CFP. 45-degree field of view. Image size 2352x1568
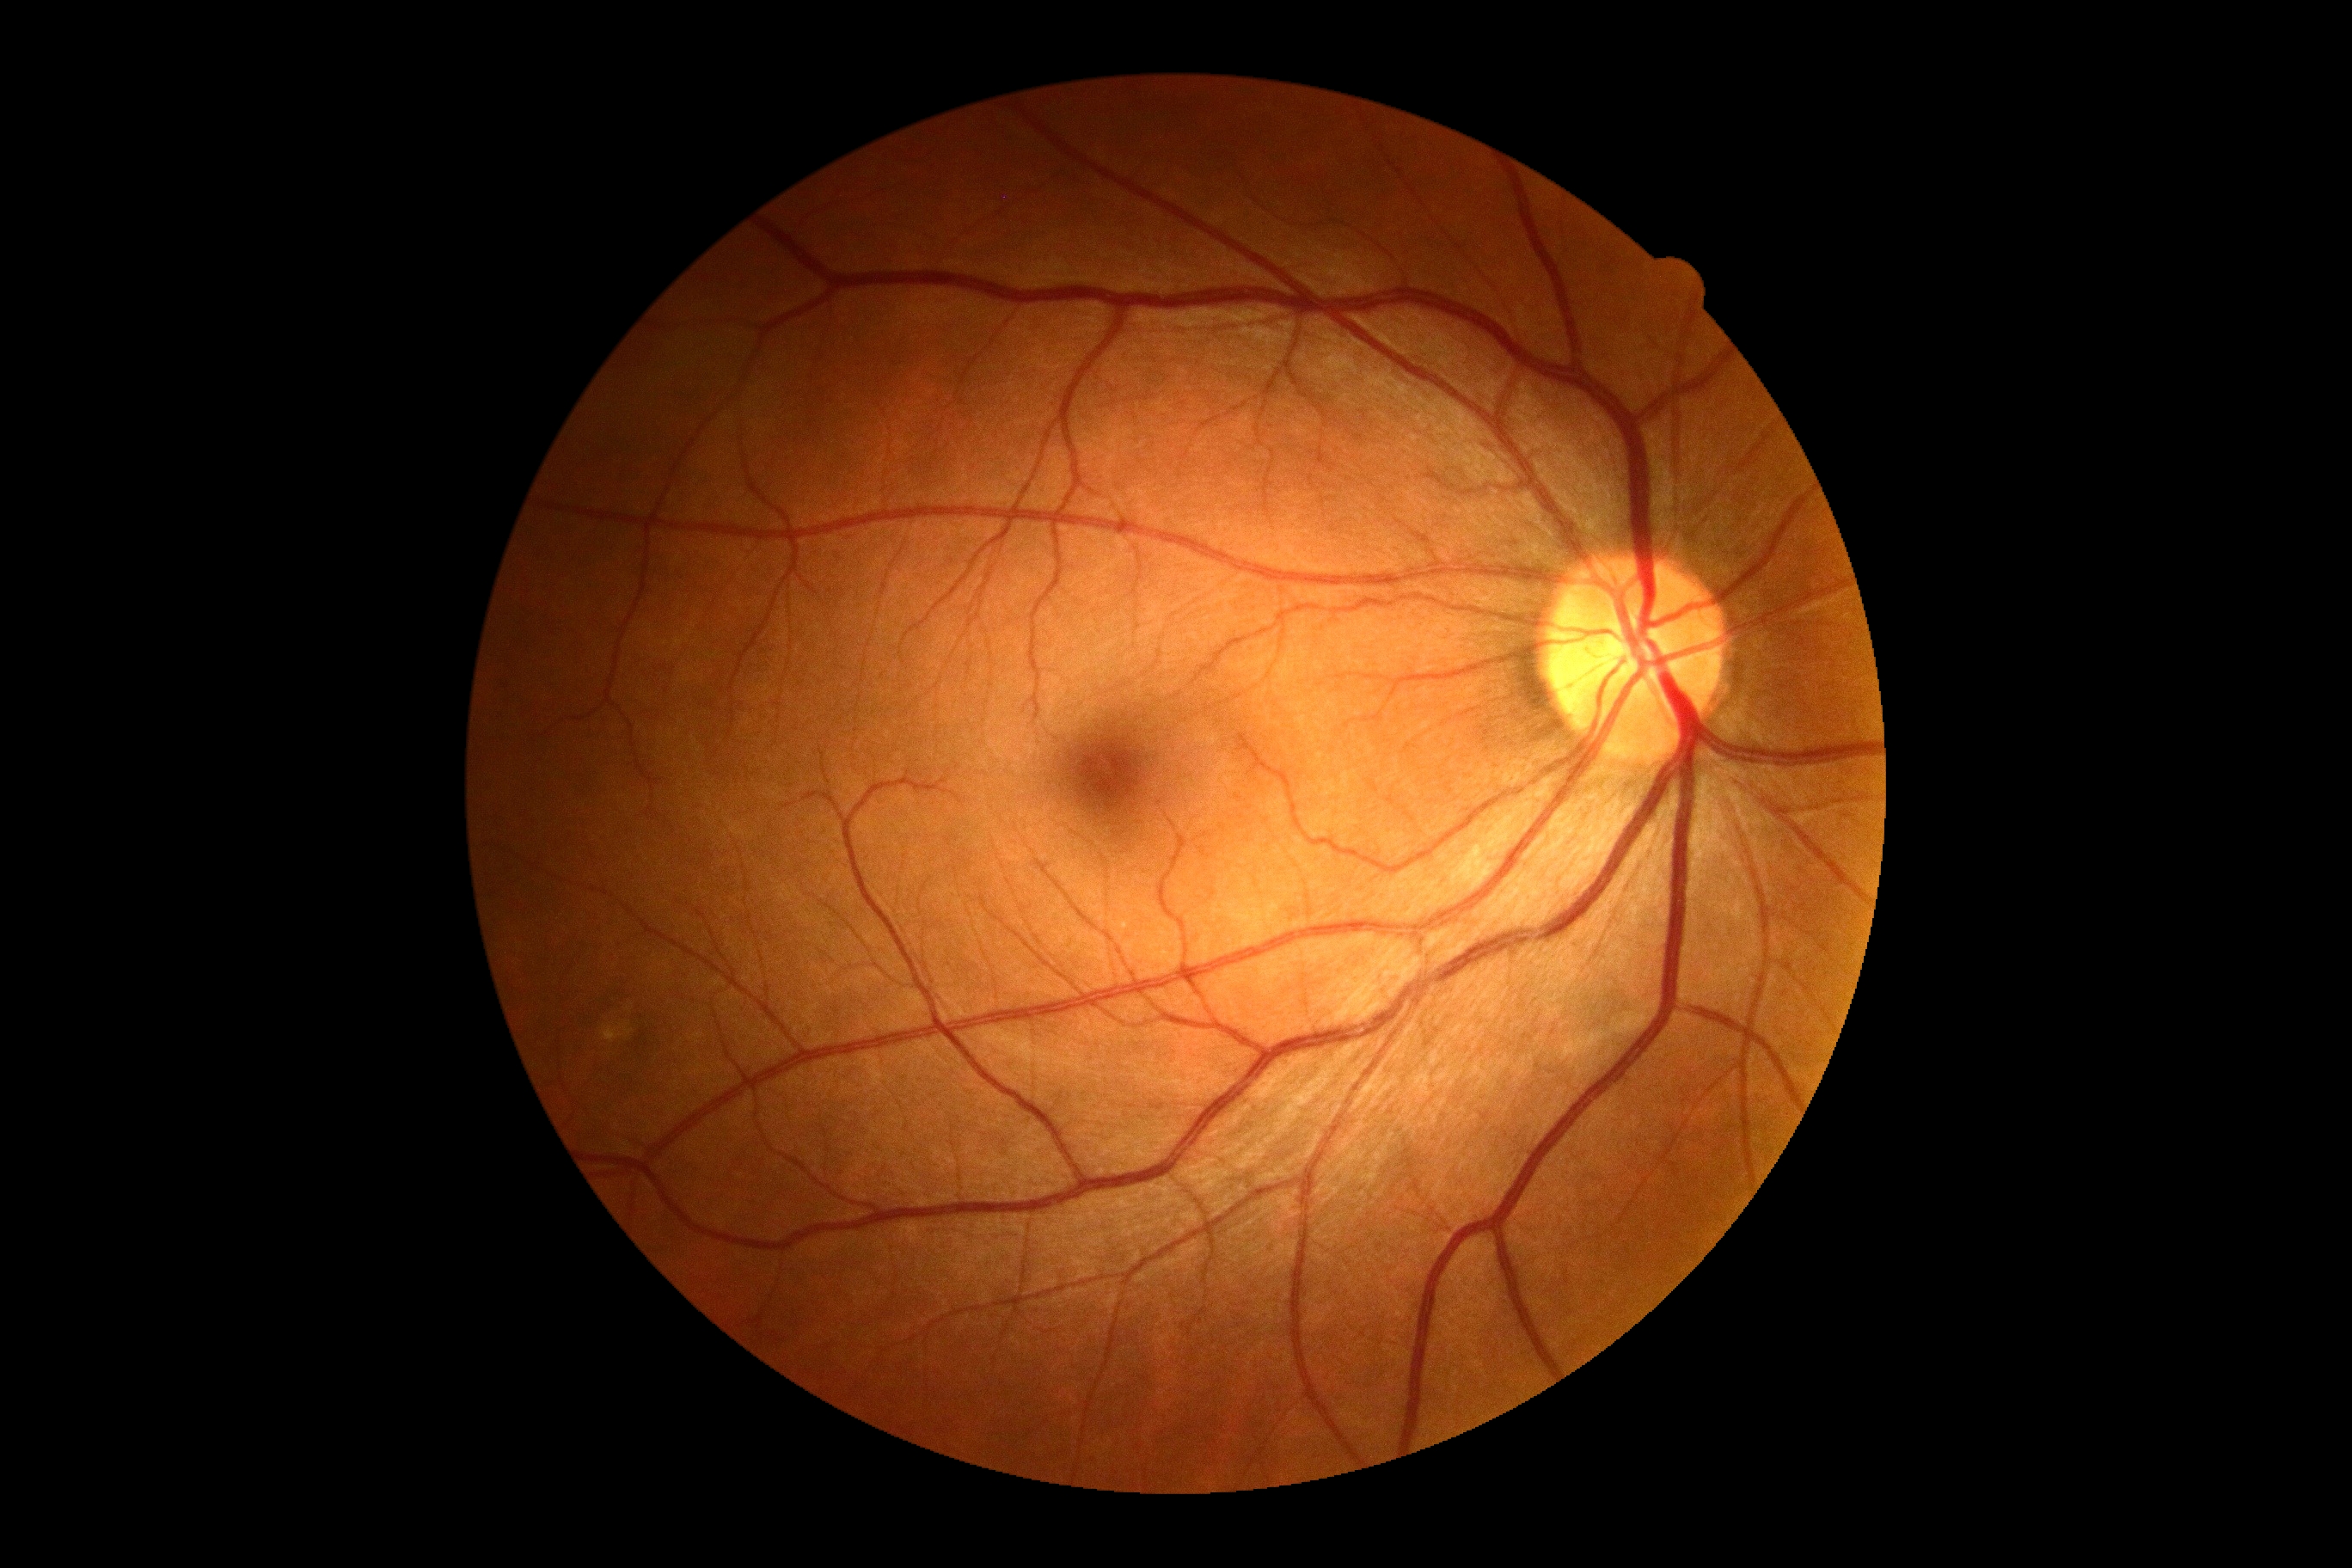

DR: grade 0.